Wide-field fundus photograph from neonatal ROP screening: 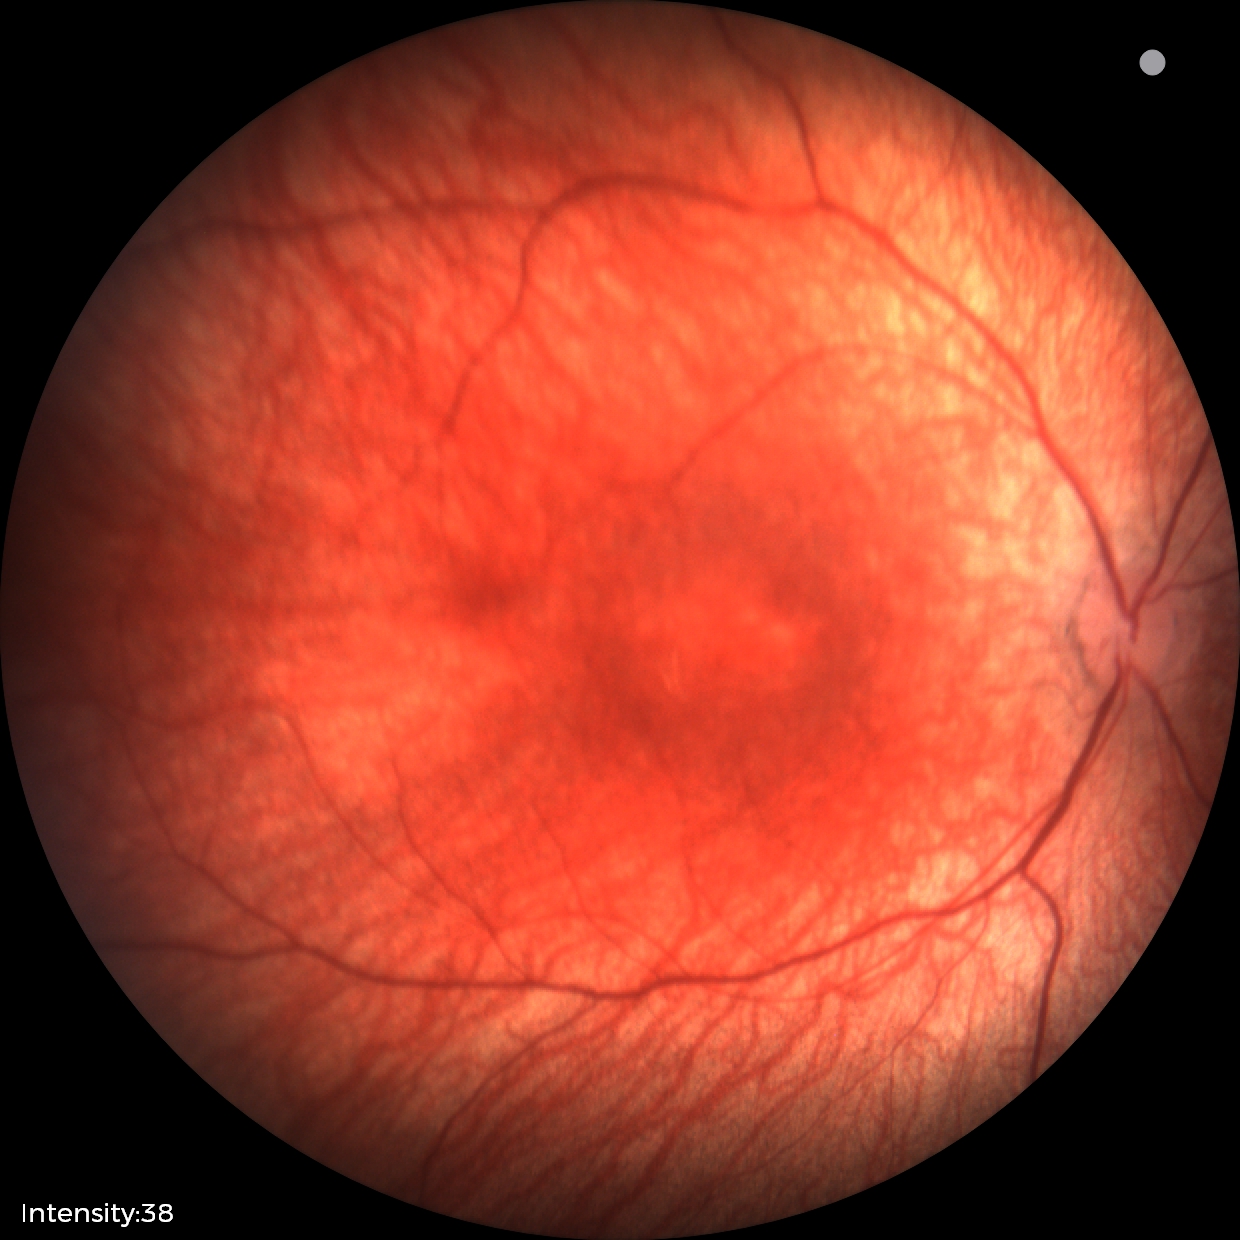

Physiological retinal appearance for postconceptual age.